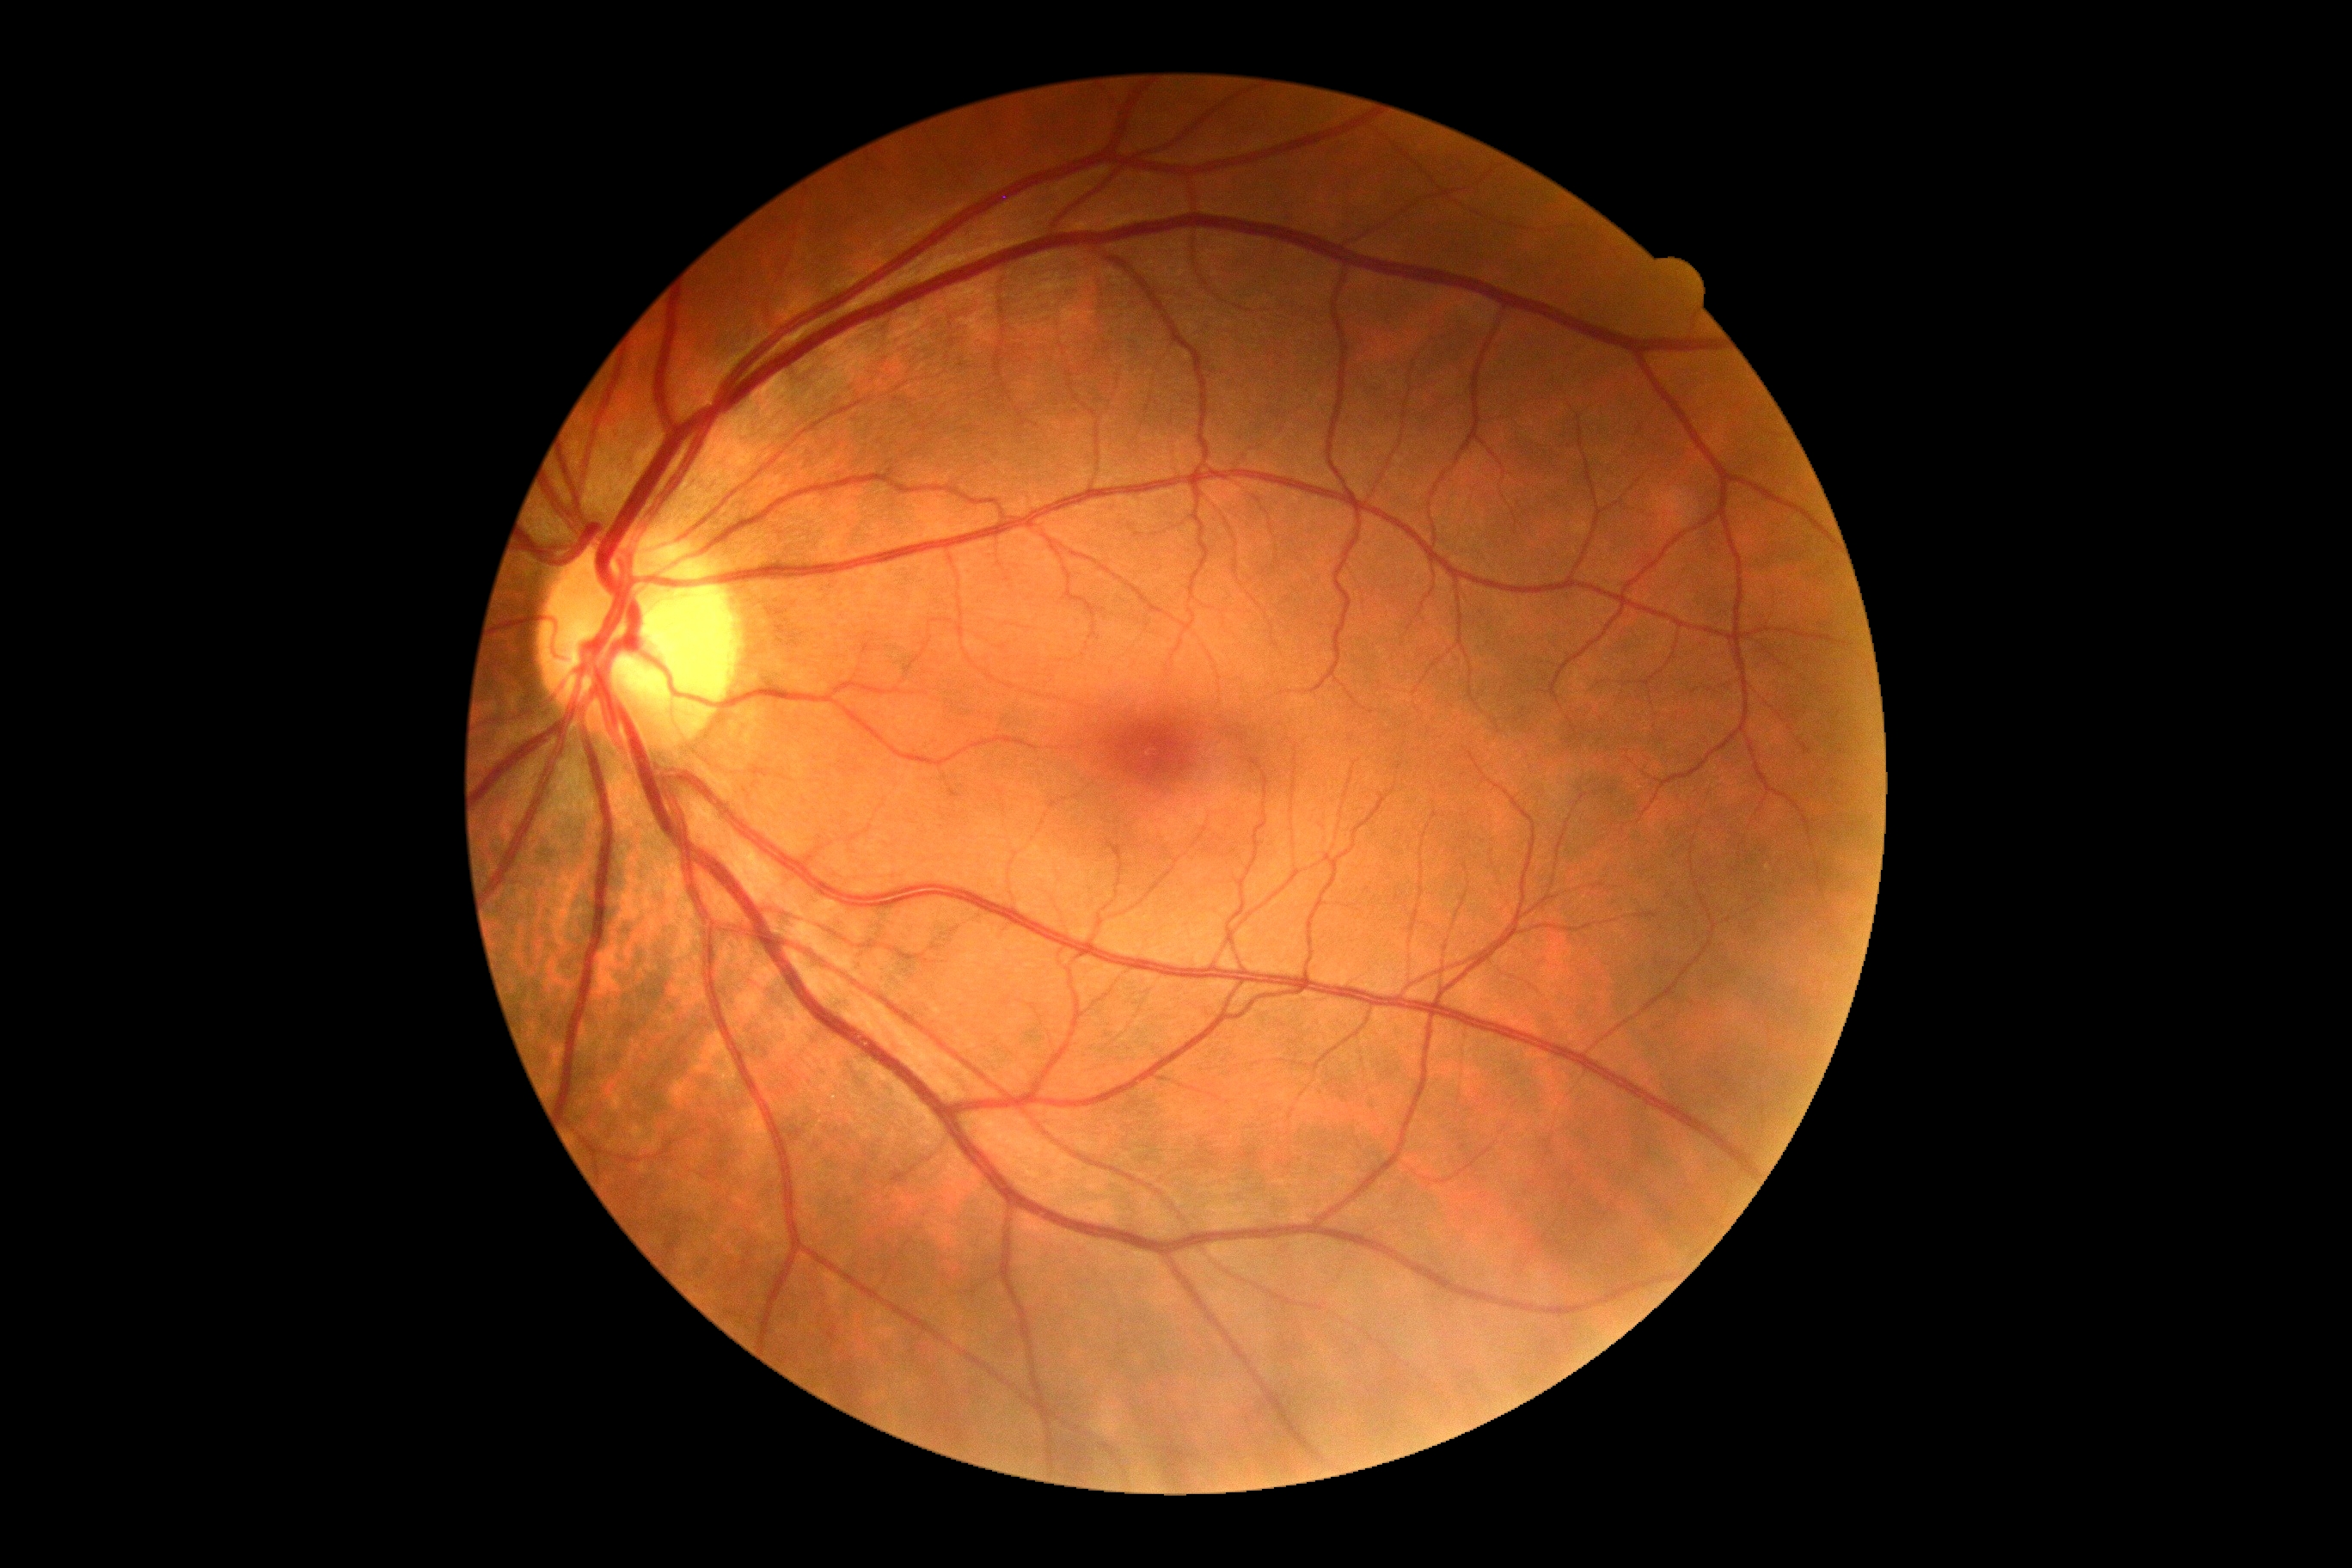

Diabetic retinopathy severity: no apparent retinopathy (grade 0).
No diabetic retinal disease findings.